Wide-field fundus photograph from neonatal ROP screening; acquired on the Phoenix ICON:
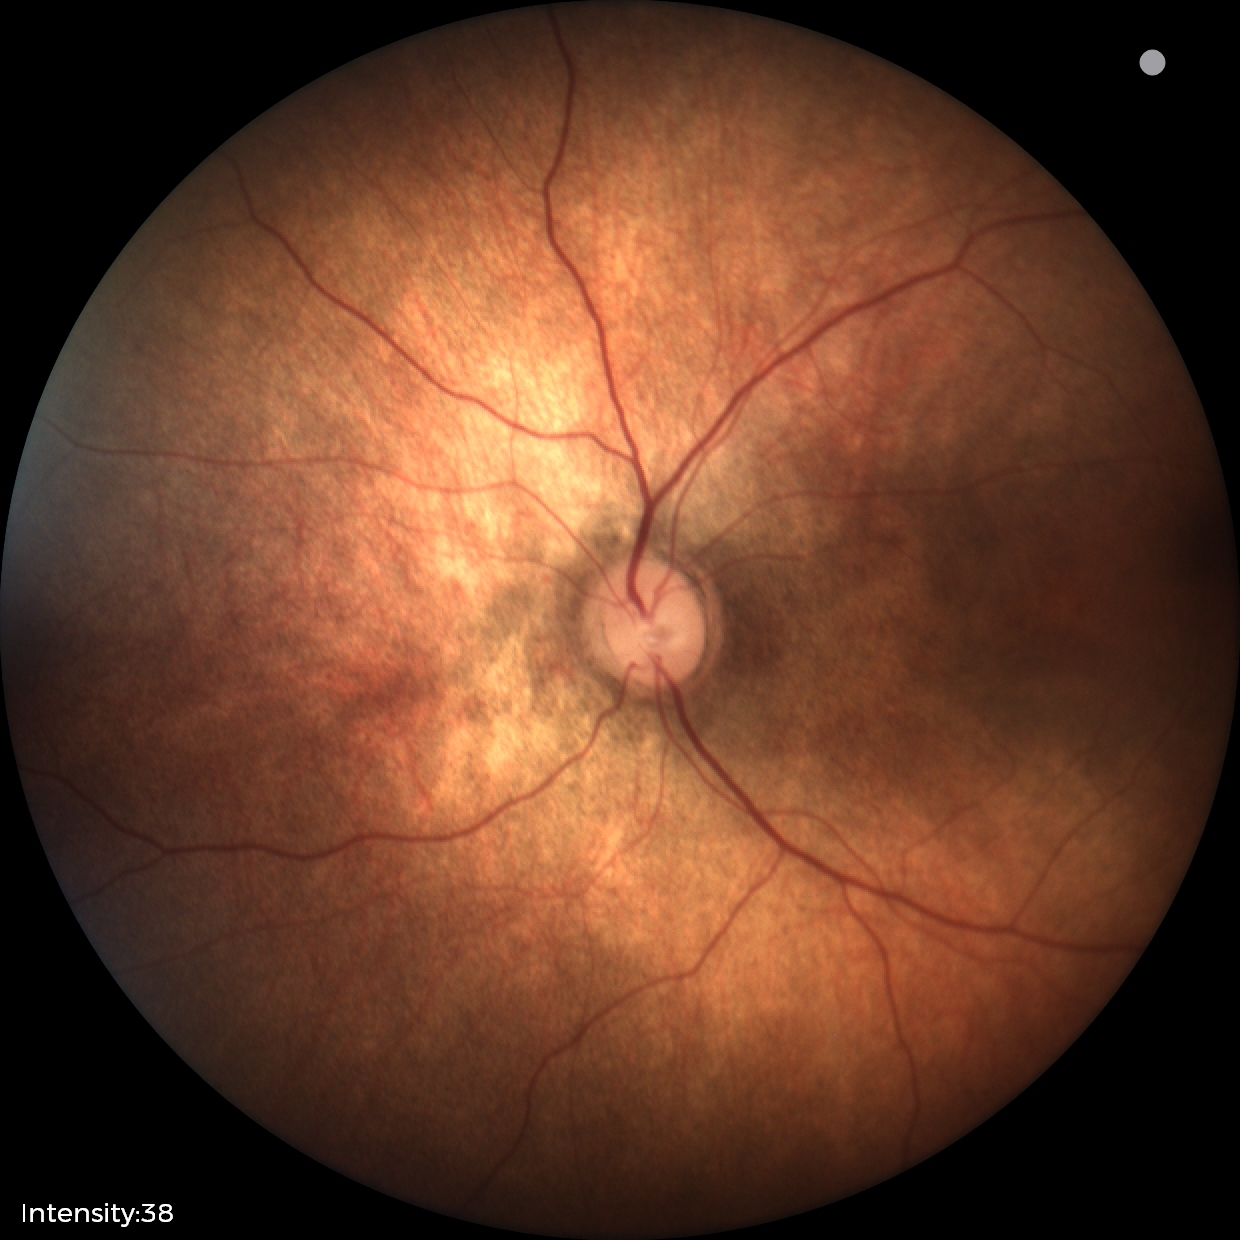

Screening examination with no abnormal retinal findings.